Fundus photo · FOV: 45 degrees — 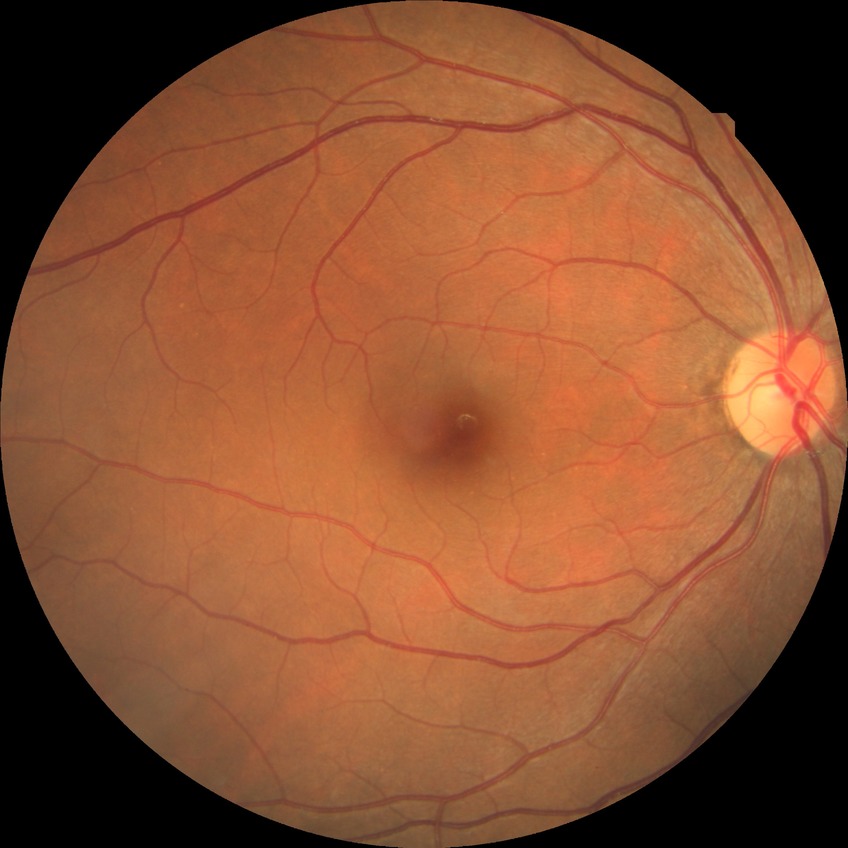

DR severity is NDR.
No signs of diabetic retinopathy.